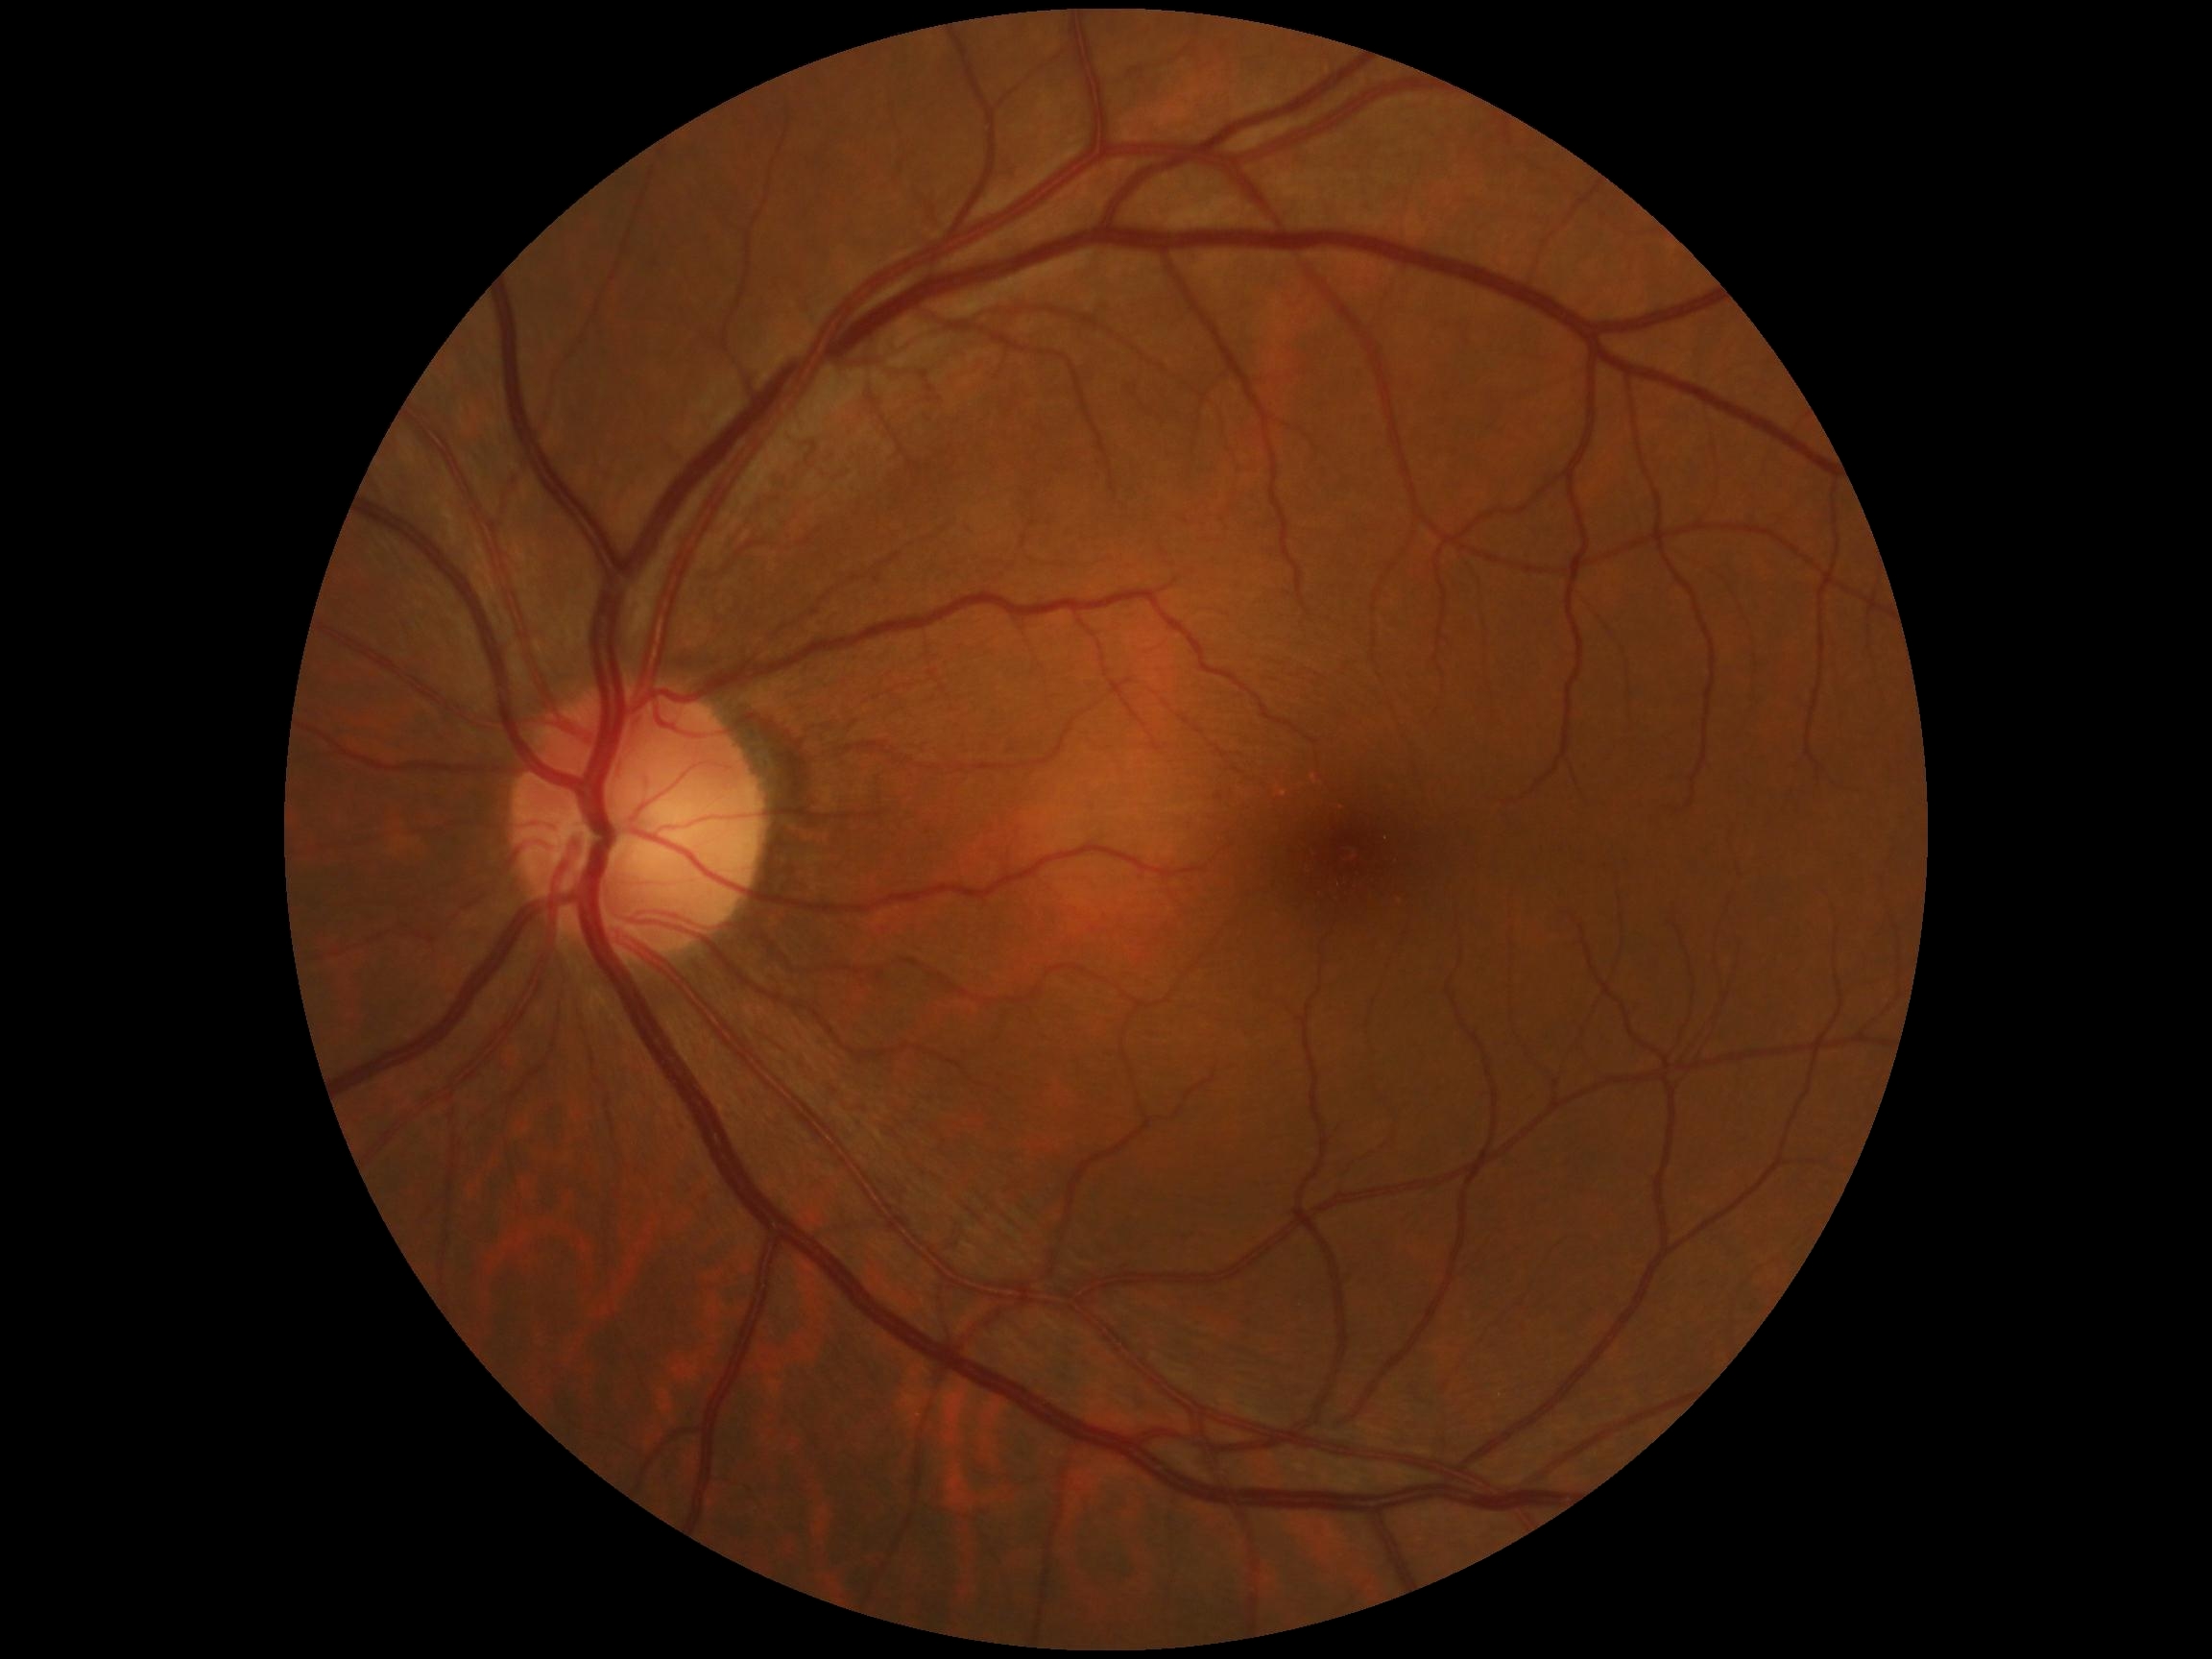 Diabetic retinopathy grade is 0.